CFP; 2048x1536: 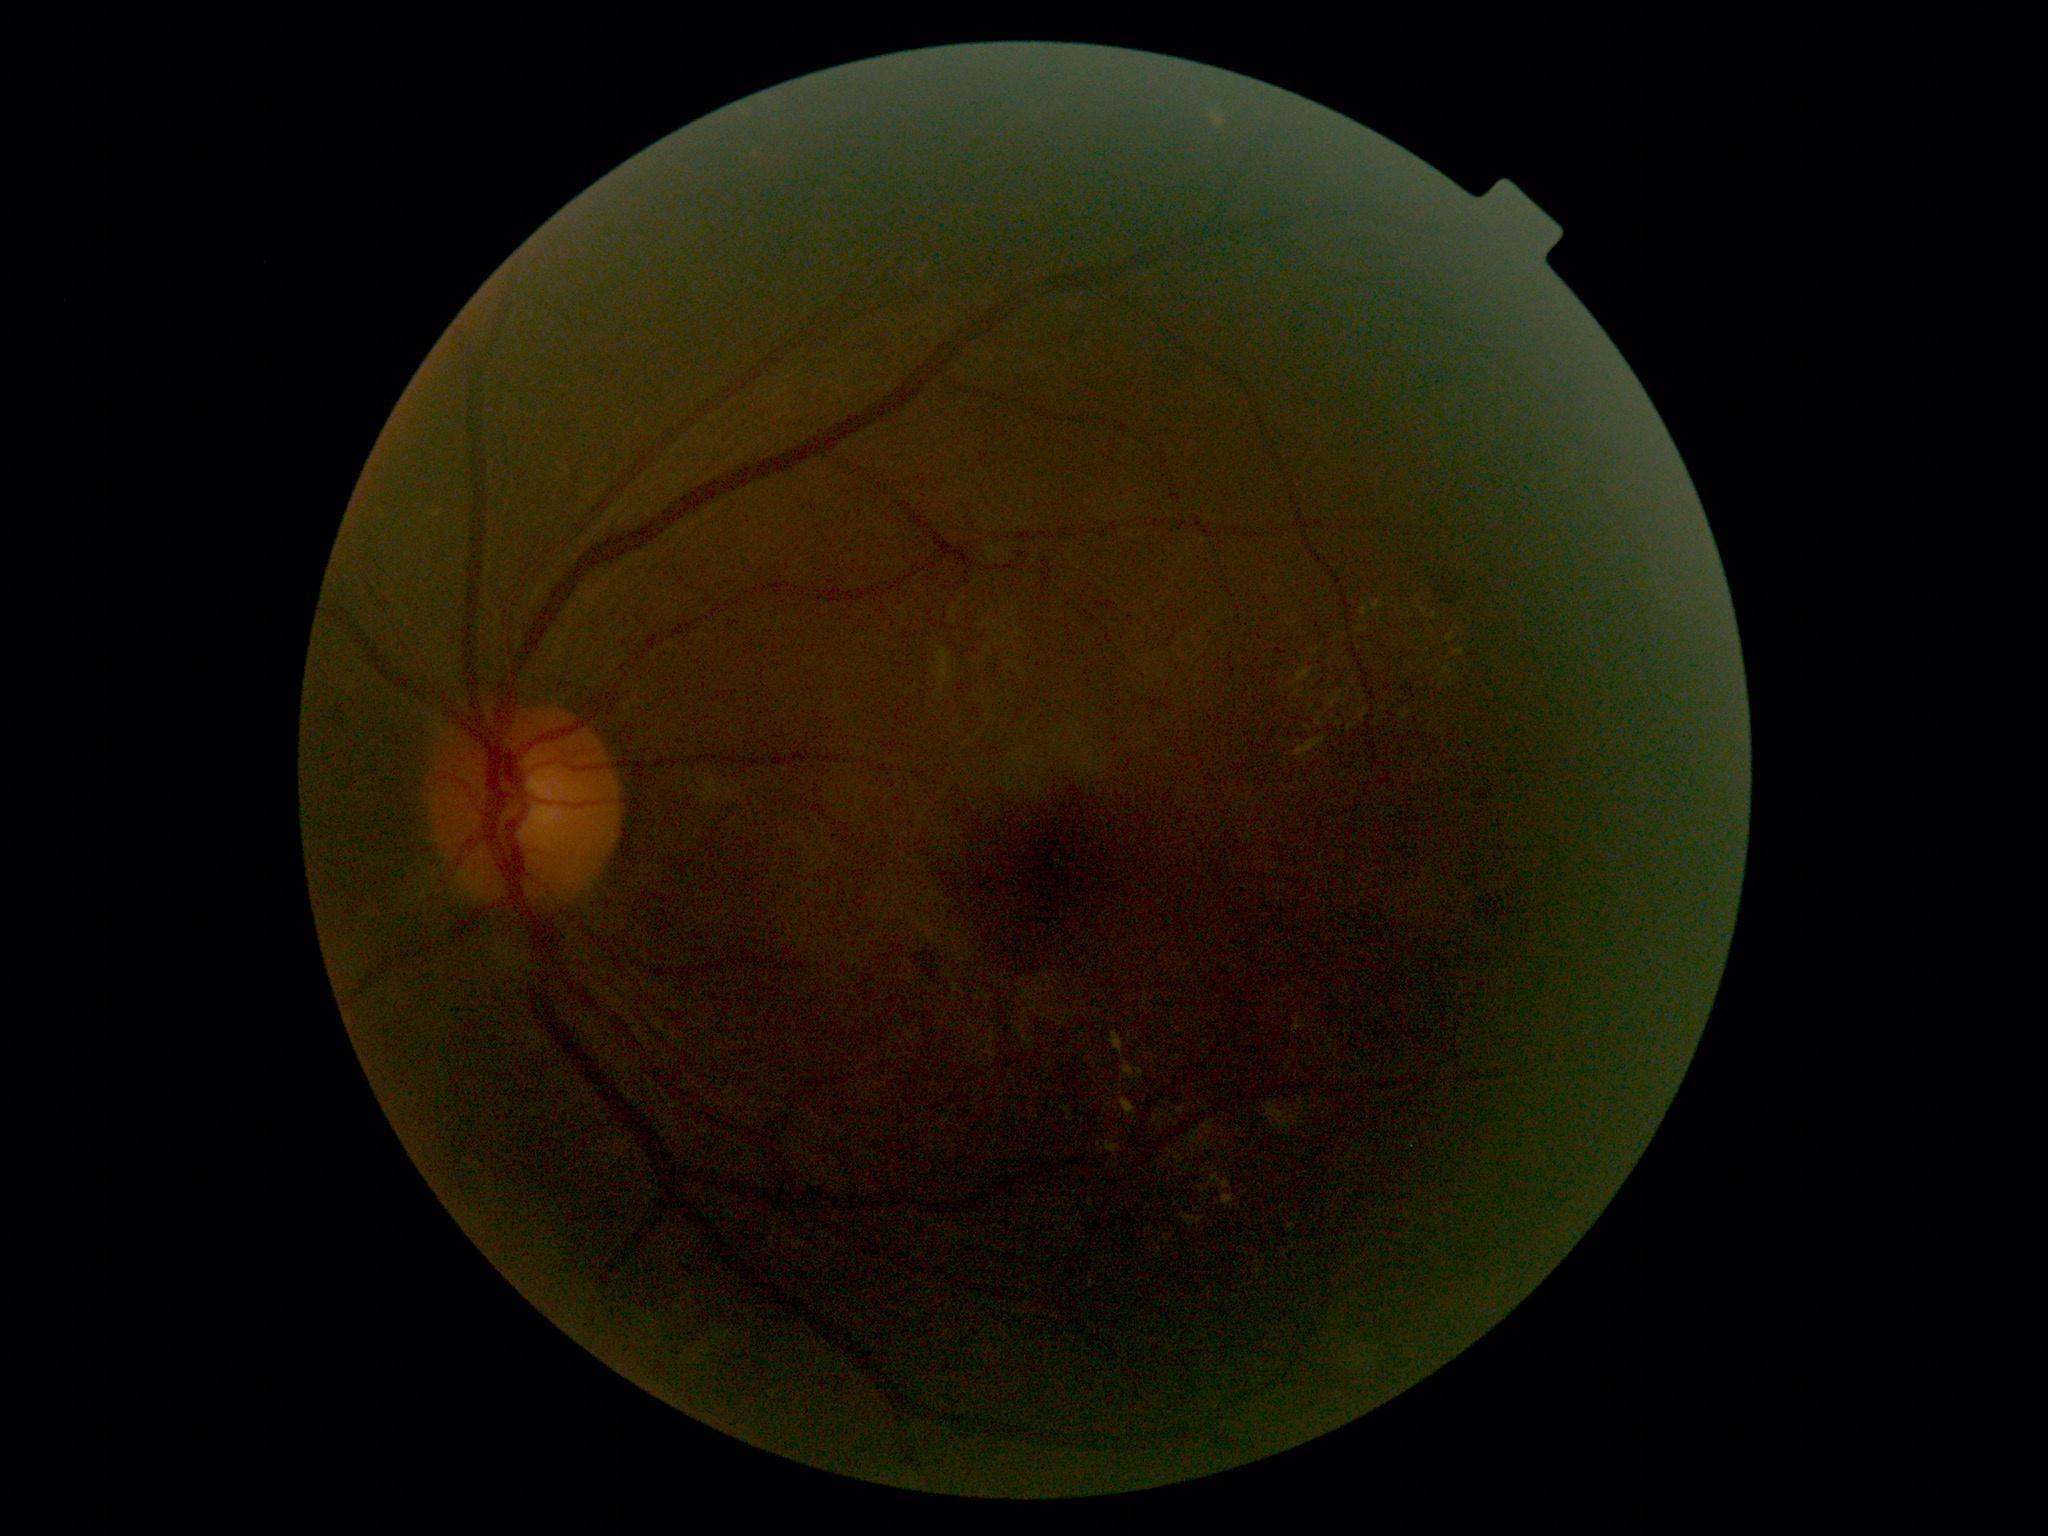

Diabetic retinopathy (DR): moderate NPDR (grade 2).
DR class: non-proliferative diabetic retinopathy.